240 by 240 pixels. Nidek AFC-330.
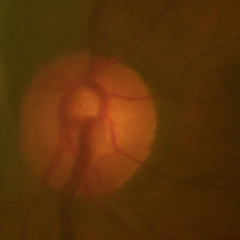

Fundus image with findings of no signs of glaucoma.